Graded on the modified Davis scale; nonmydriatic fundus photograph — 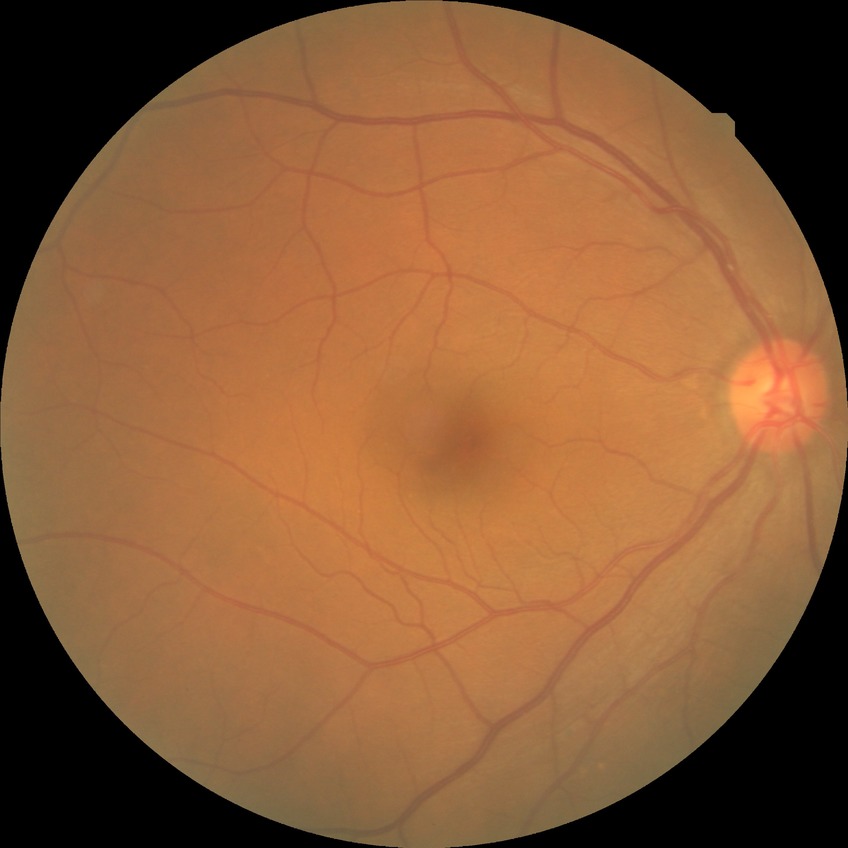
diabetic retinopathy stage = no diabetic retinopathy.